1240 x 1240 pixels · wide-field fundus photograph from neonatal ROP screening — 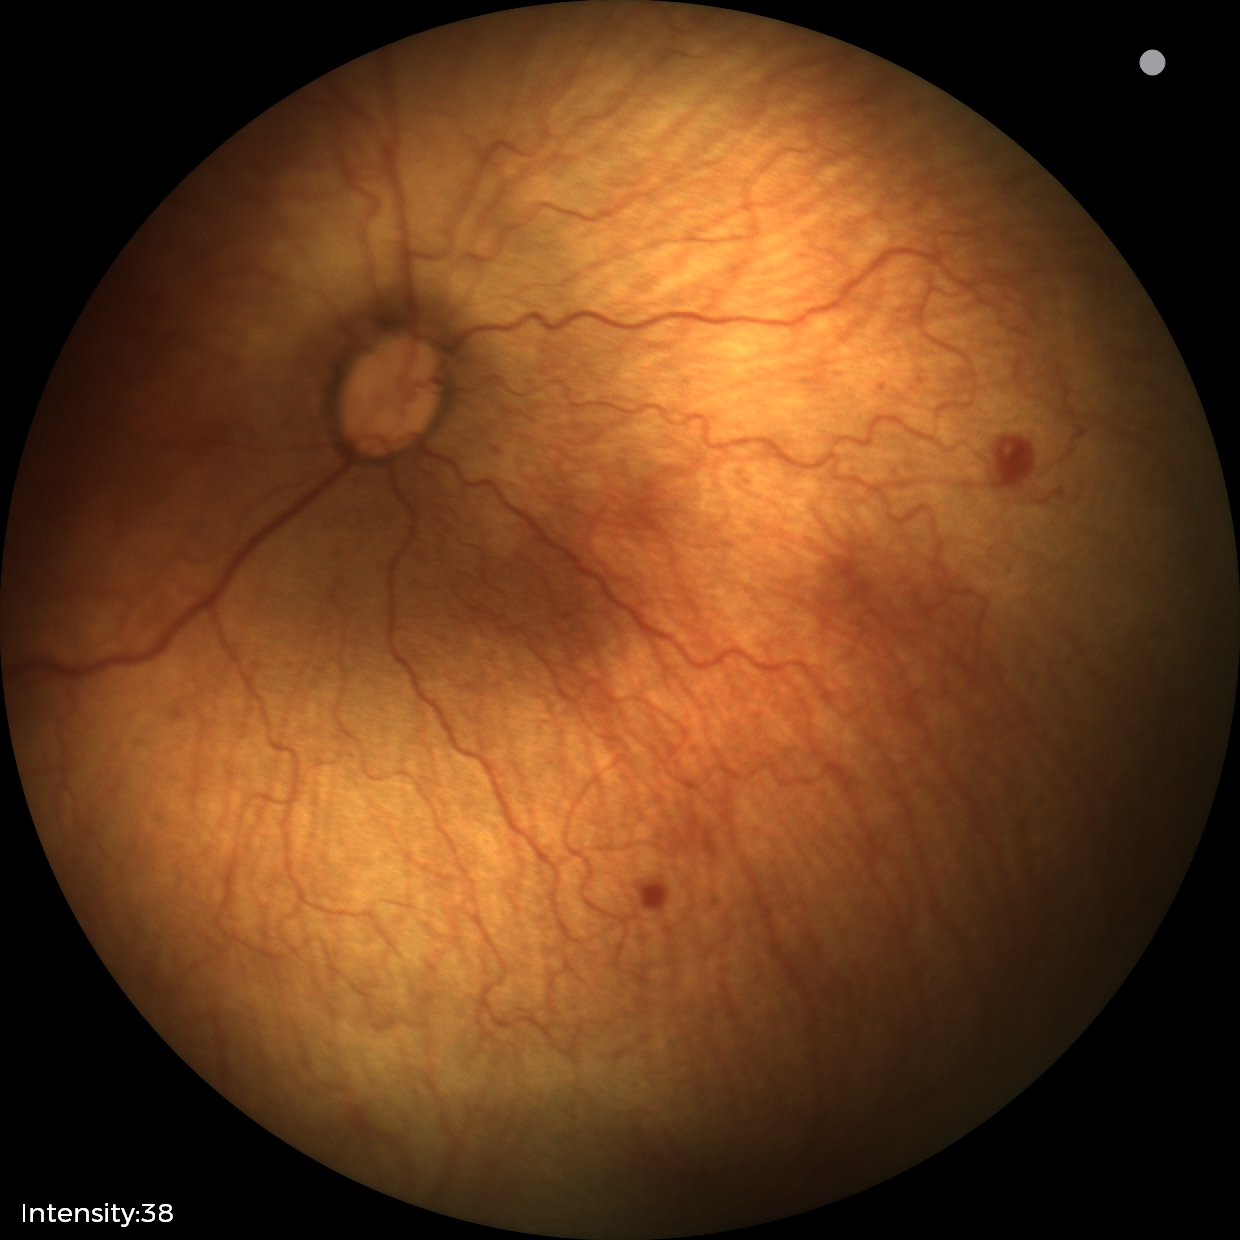
Q: What is the diagnosis from this examination?
A: retinopathy of prematurity stage 1 — demarcation line between vascular and avascular retina
Q: Is plus disease present?
A: no plus disease — posterior pole vessels without abnormal dilation or tortuosity